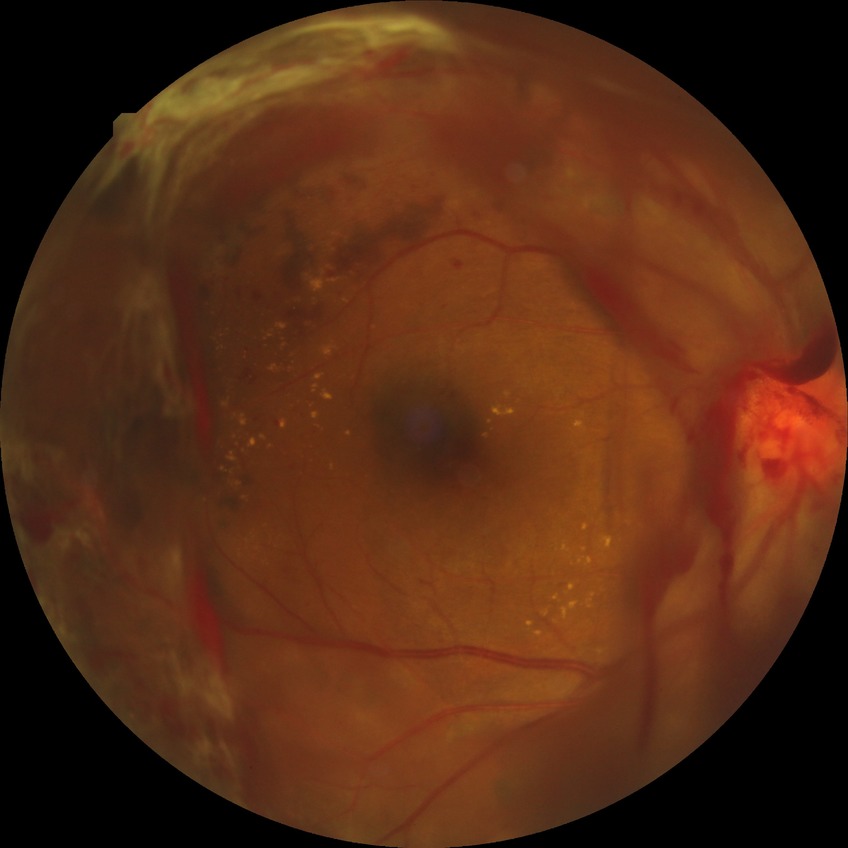

{"davis_grade": "PDR (proliferative diabetic retinopathy)"}